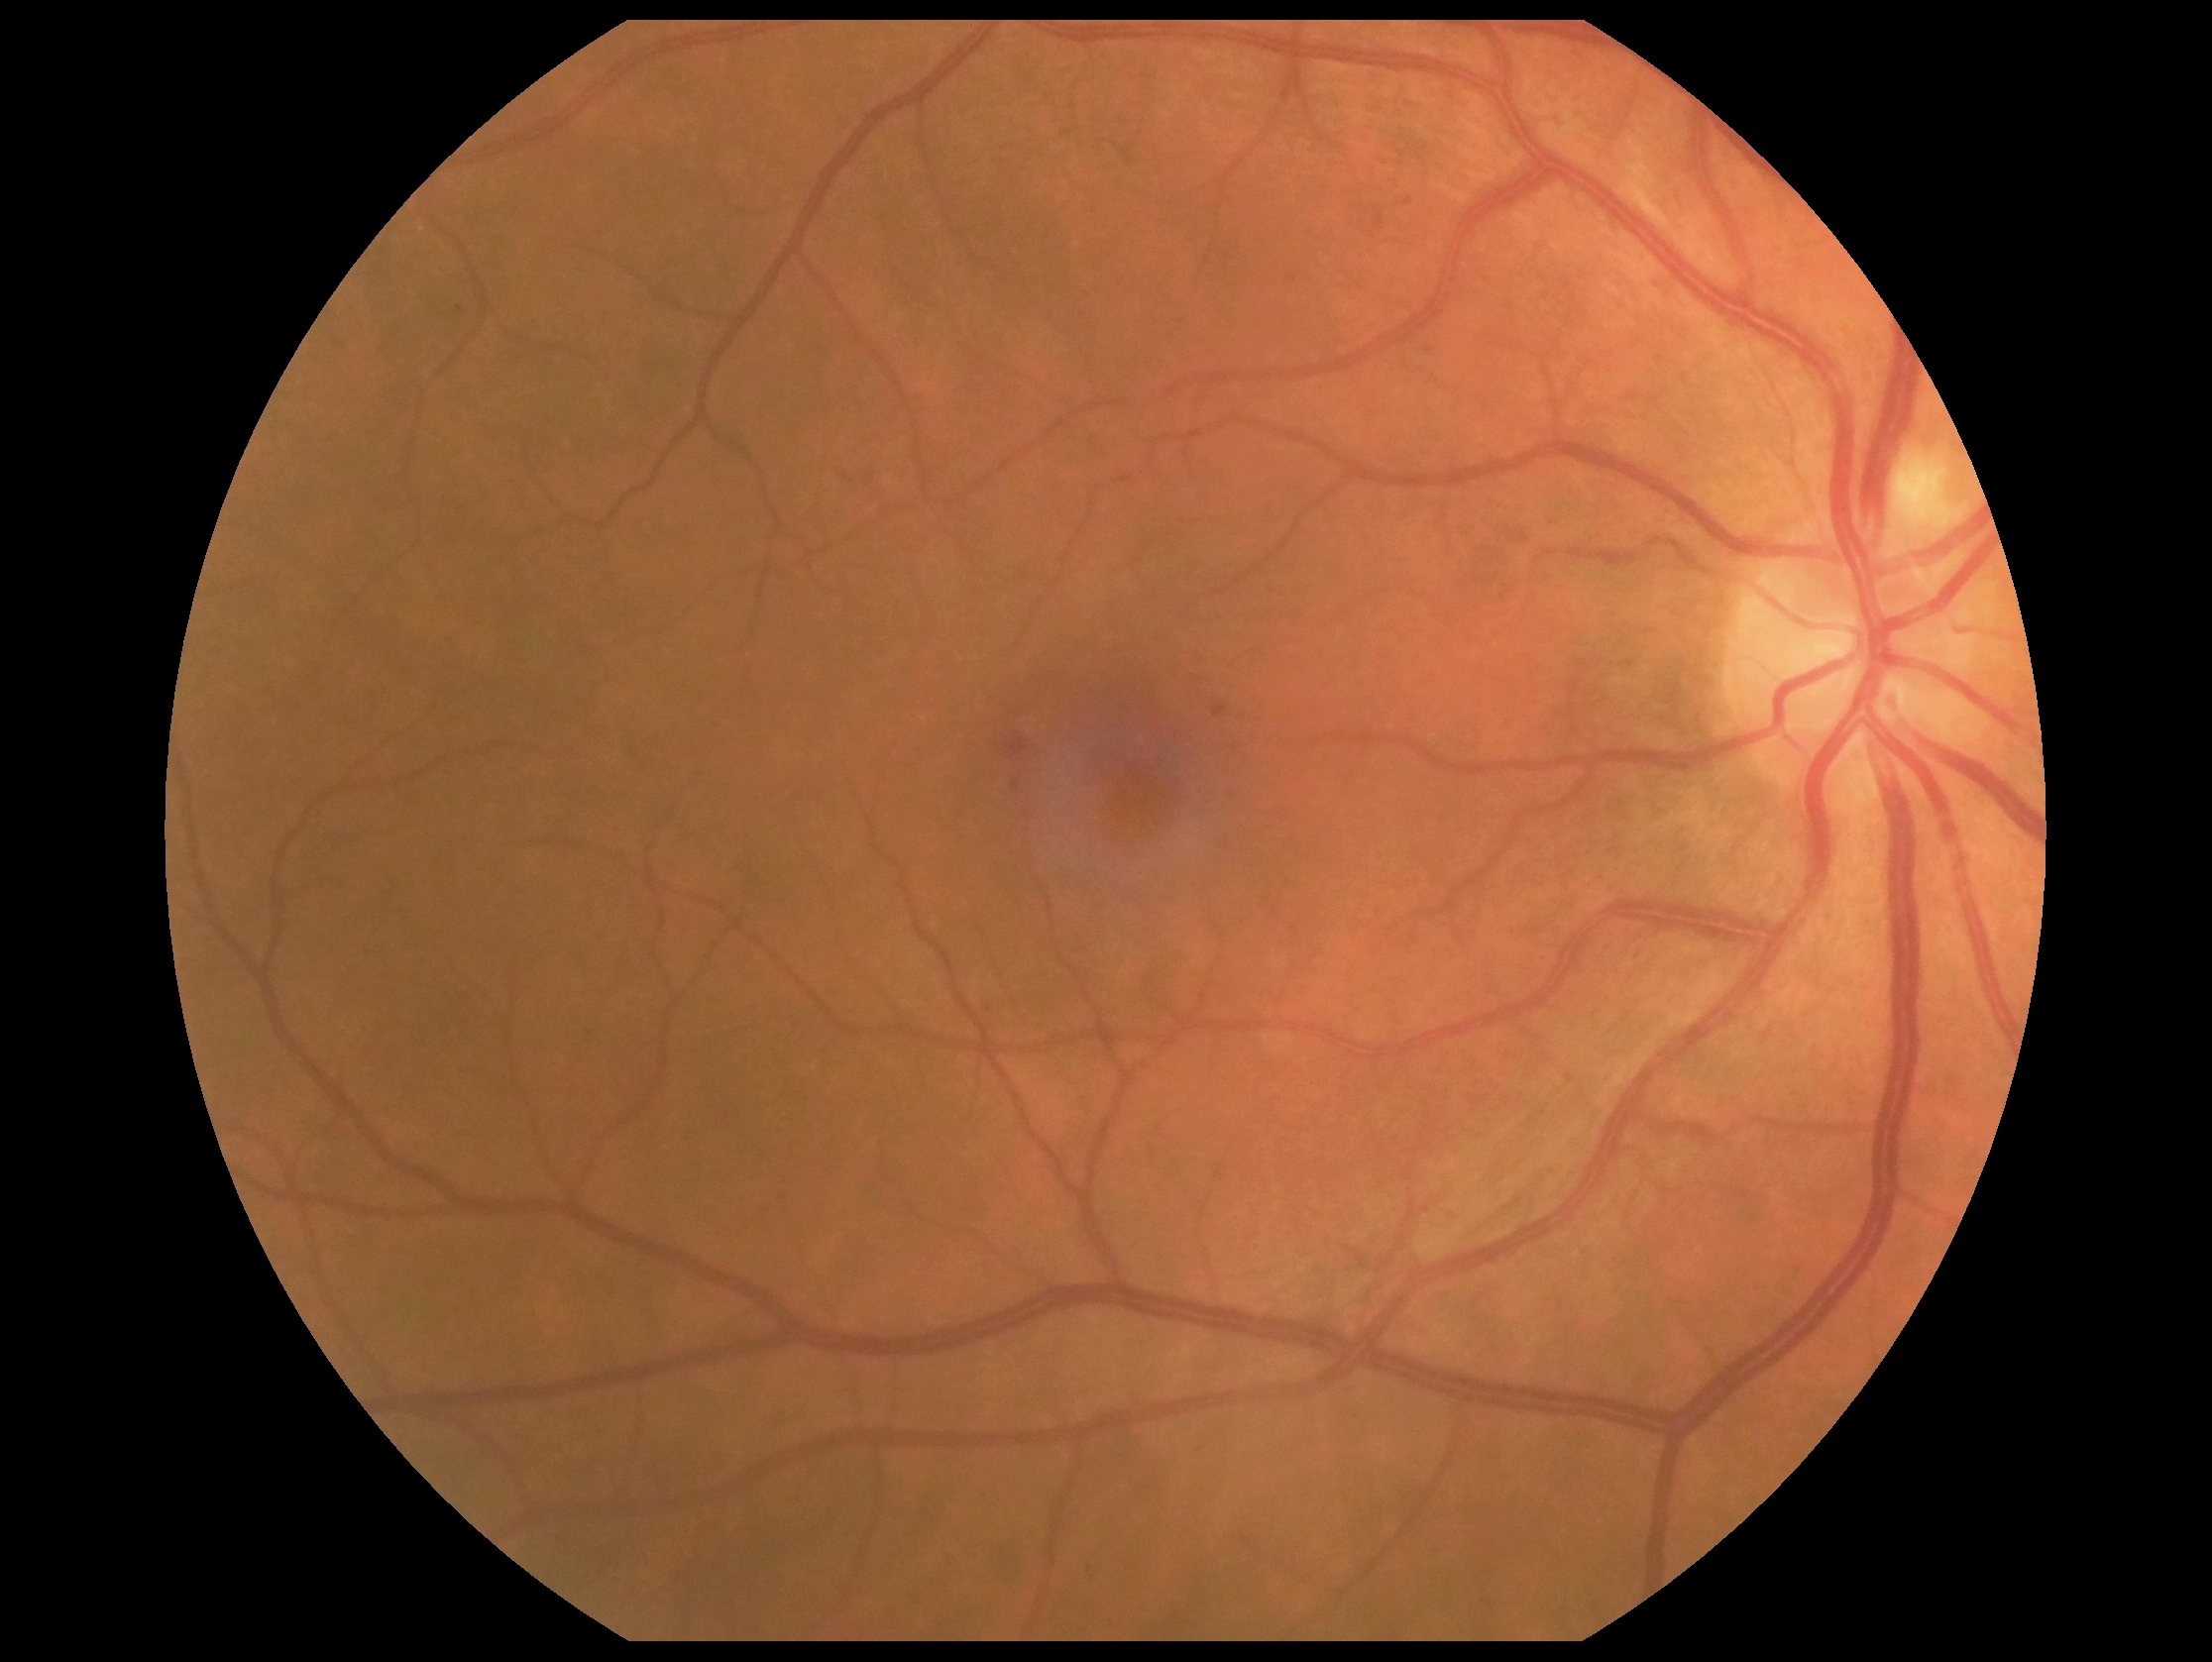

Annotations:
- diabetic retinopathy: grade 2 (moderate NPDR)